Female
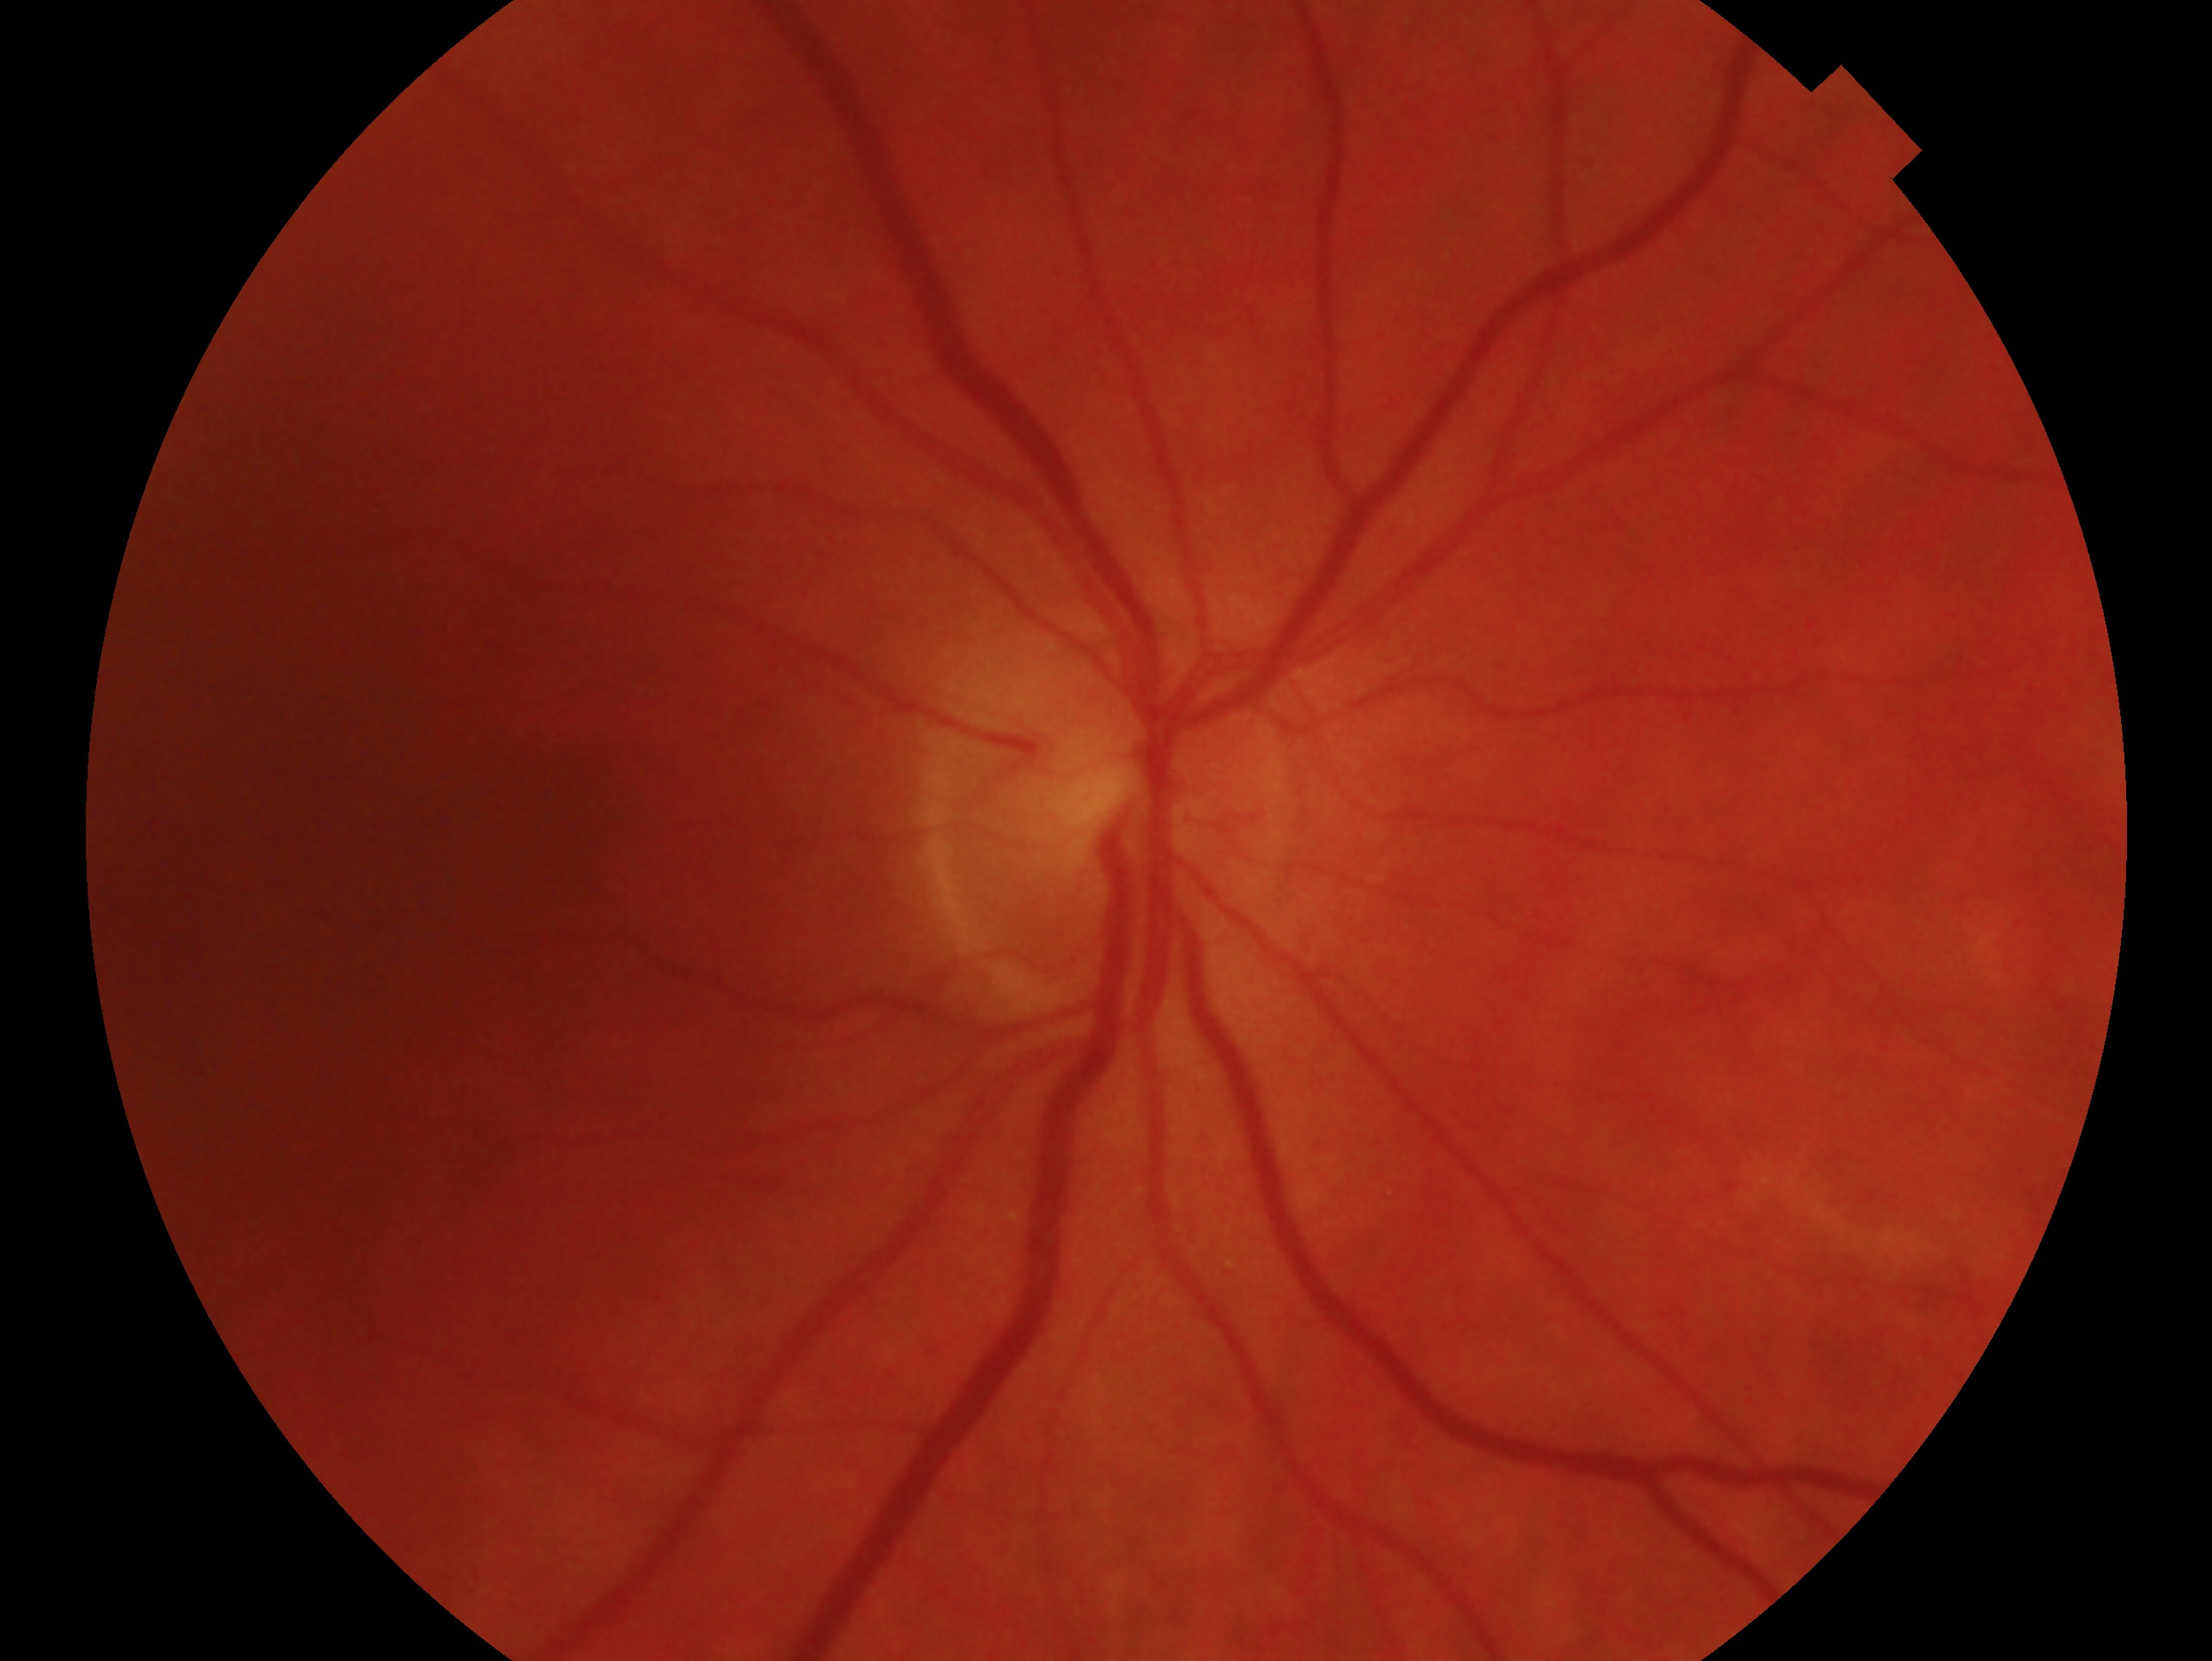

Findings:
• impression — no glaucoma
• laterality — right